Wide-field retinal mosaic image — 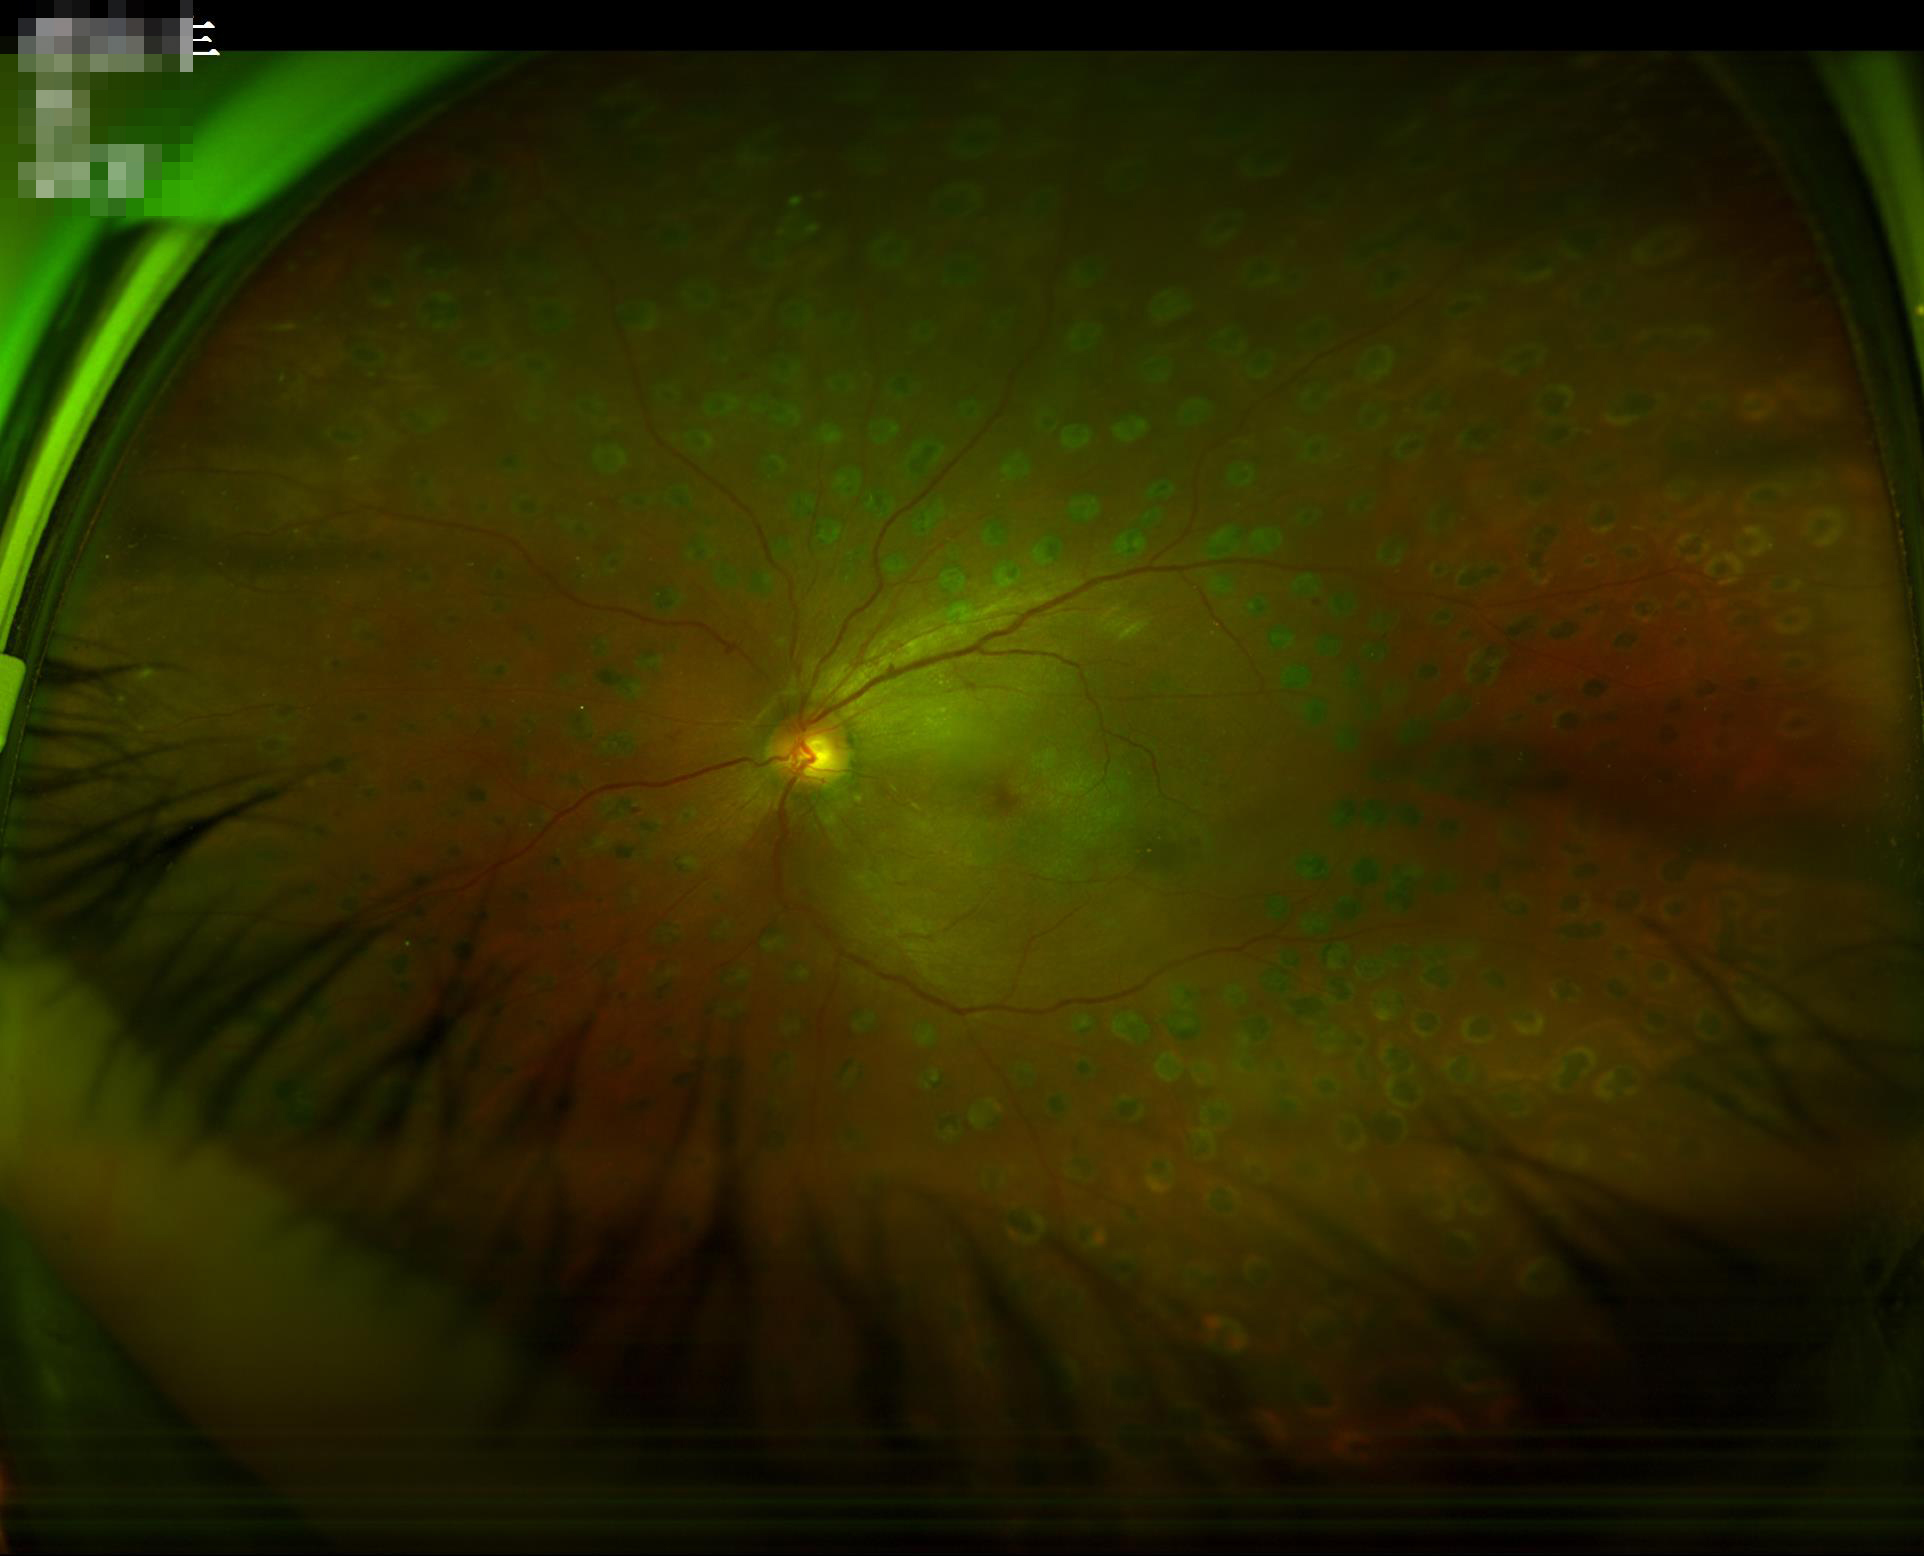
Acceptable image quality.
There is over- or under-exposure or a color cast.
Good dynamic range.